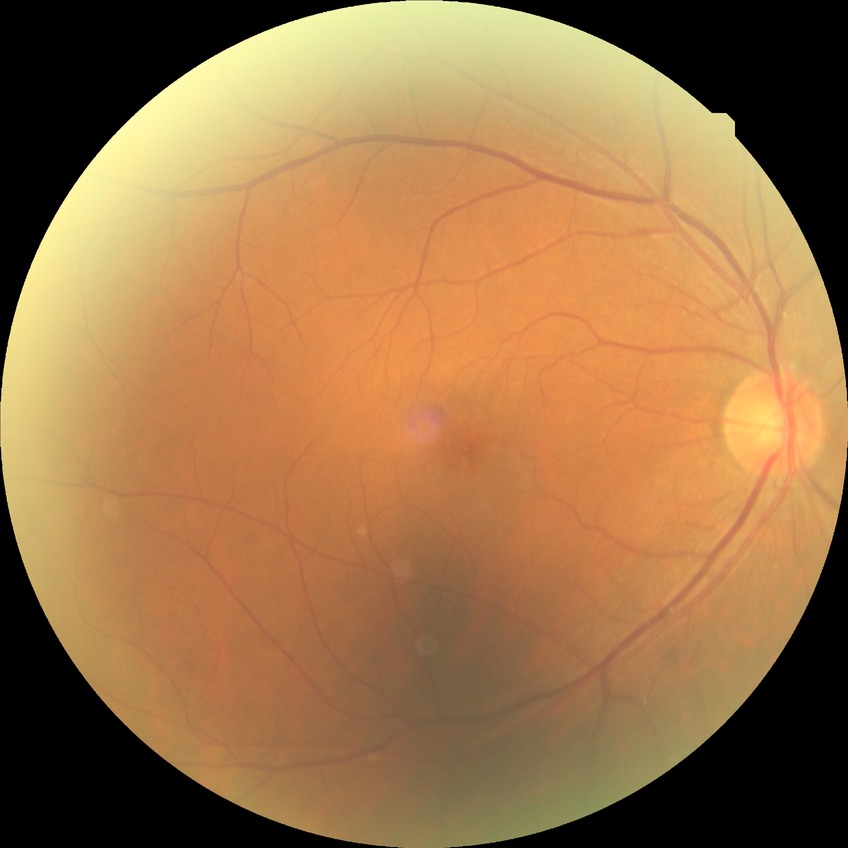 The retinopathy is classified as non-proliferative diabetic retinopathy. Diabetic retinopathy severity: simple diabetic retinopathy.